FOV: 45 degrees · CFP · 2352x1568:
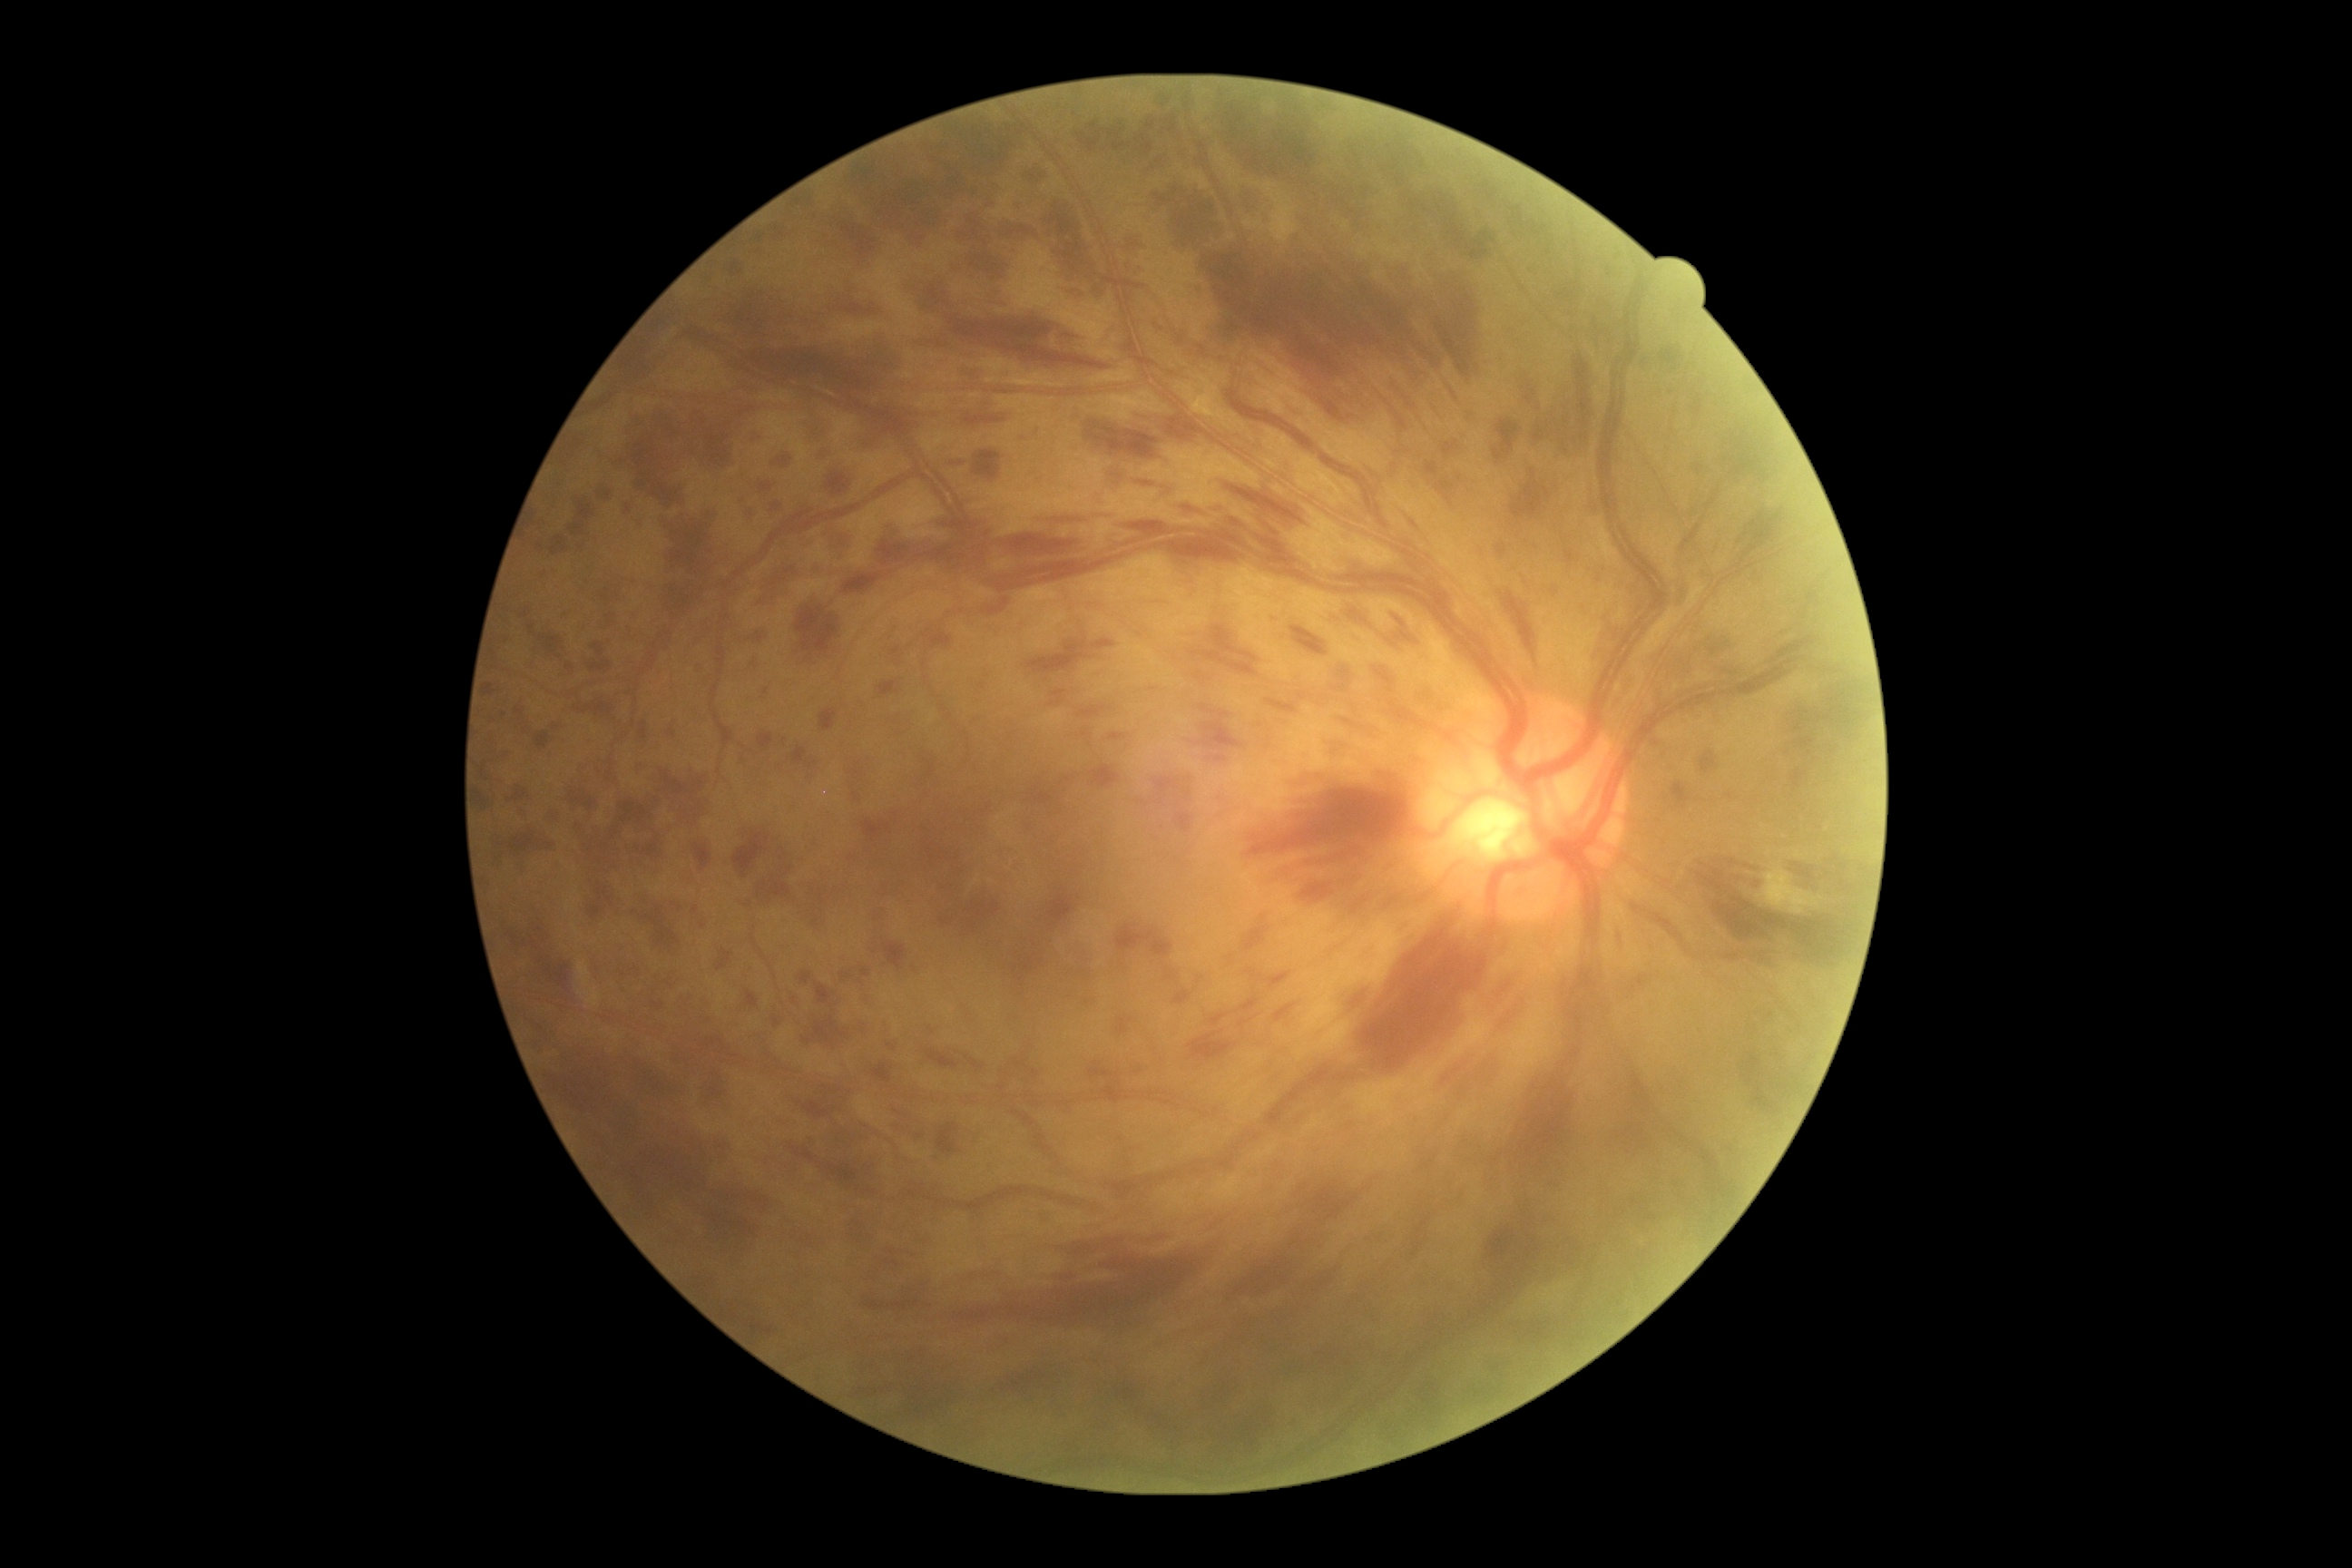 - retinopathy: severe non-proliferative diabetic retinopathy (grade 3)
- DR class: non-proliferative diabetic retinopathy